45° field of view
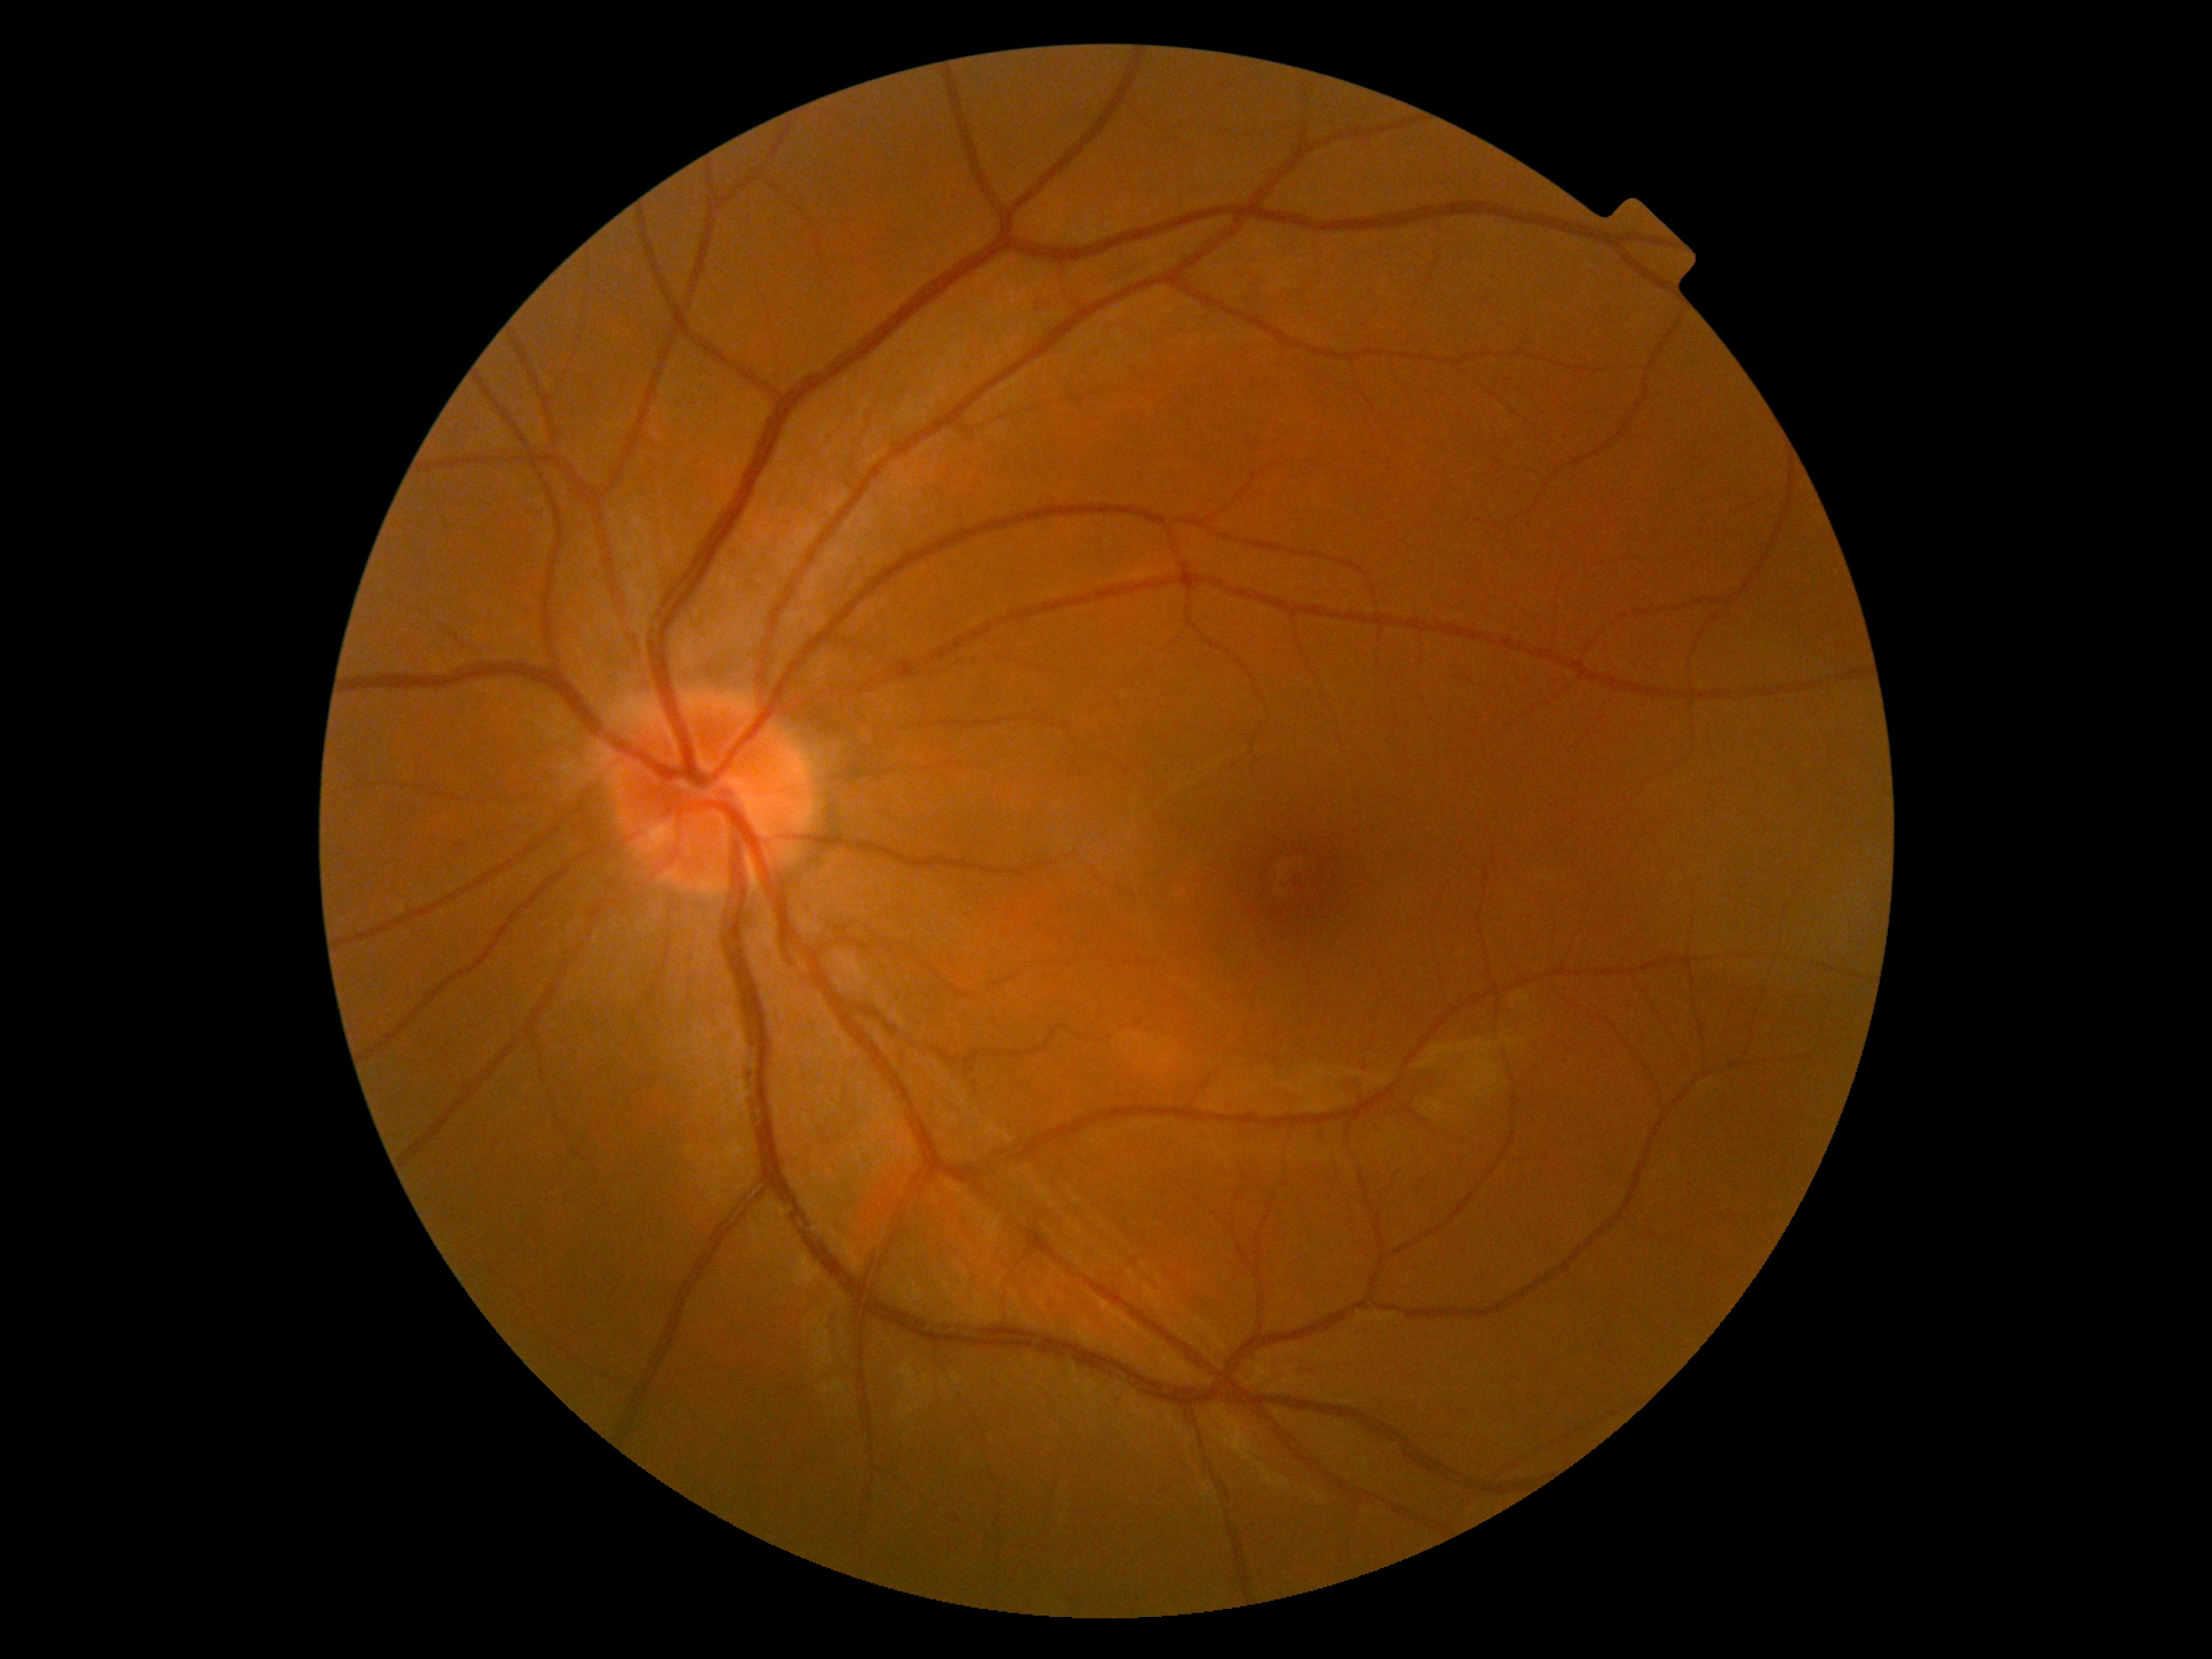 DR severity: grade 0.